Modified Davis classification, 848 by 848 pixels, no pharmacologic dilation:
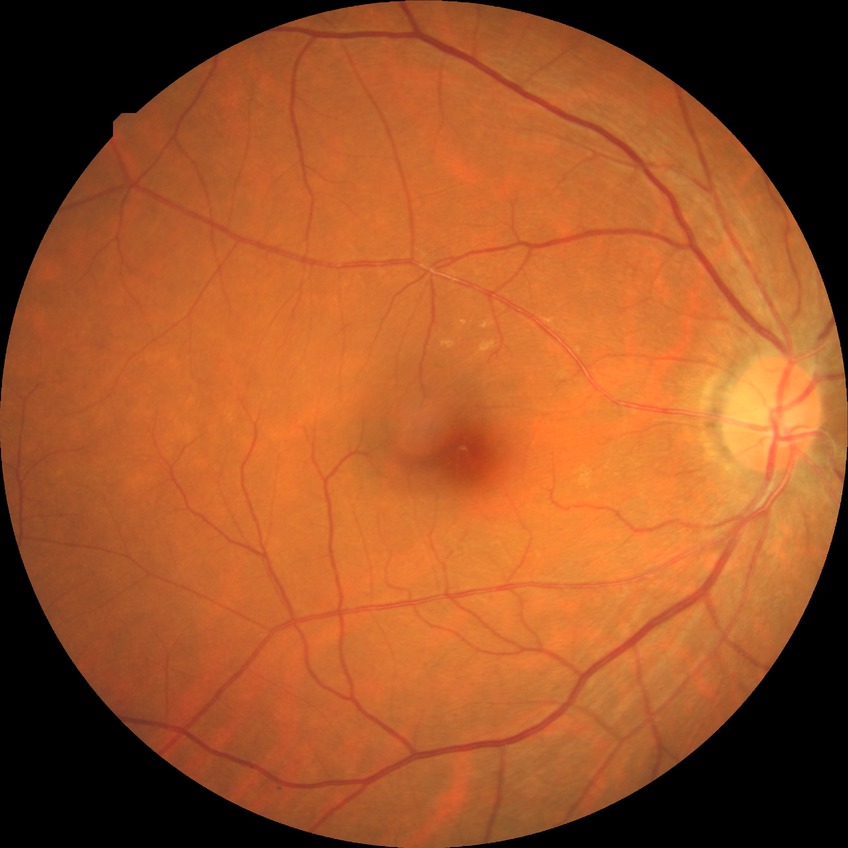

Diabetic retinopathy stage: no diabetic retinopathy.